Wide-field fundus photograph from neonatal ROP screening
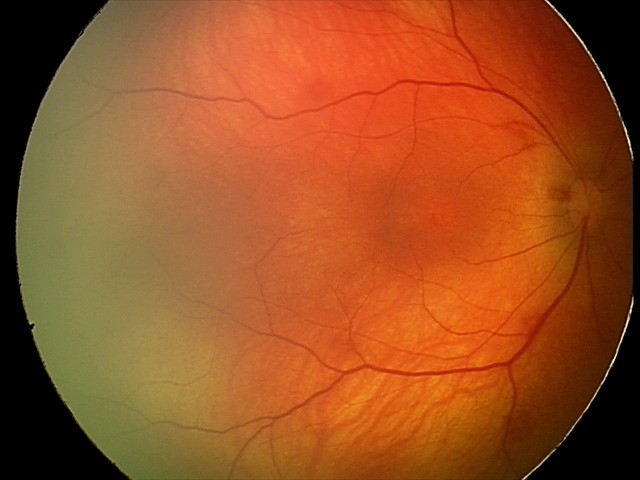
Impression = retinal hemorrhages.